45 degree fundus photograph, DR severity per modified Davis staging, without pupil dilation, posterior pole photograph.
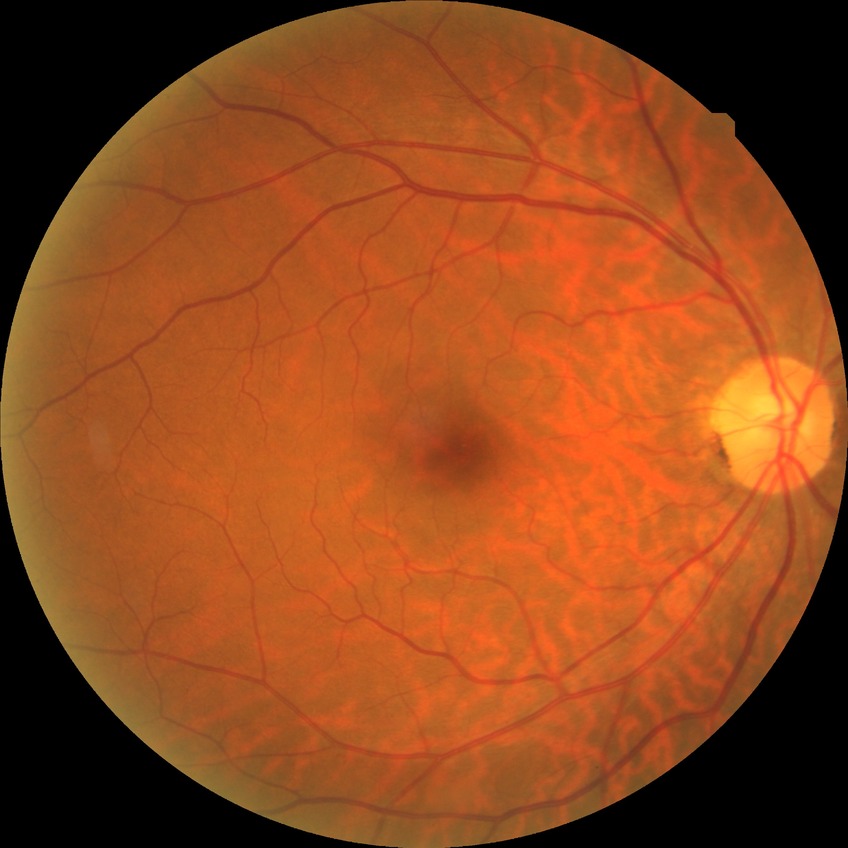

DR grade: NDR.